Image size 1932x1910, color fundus image: 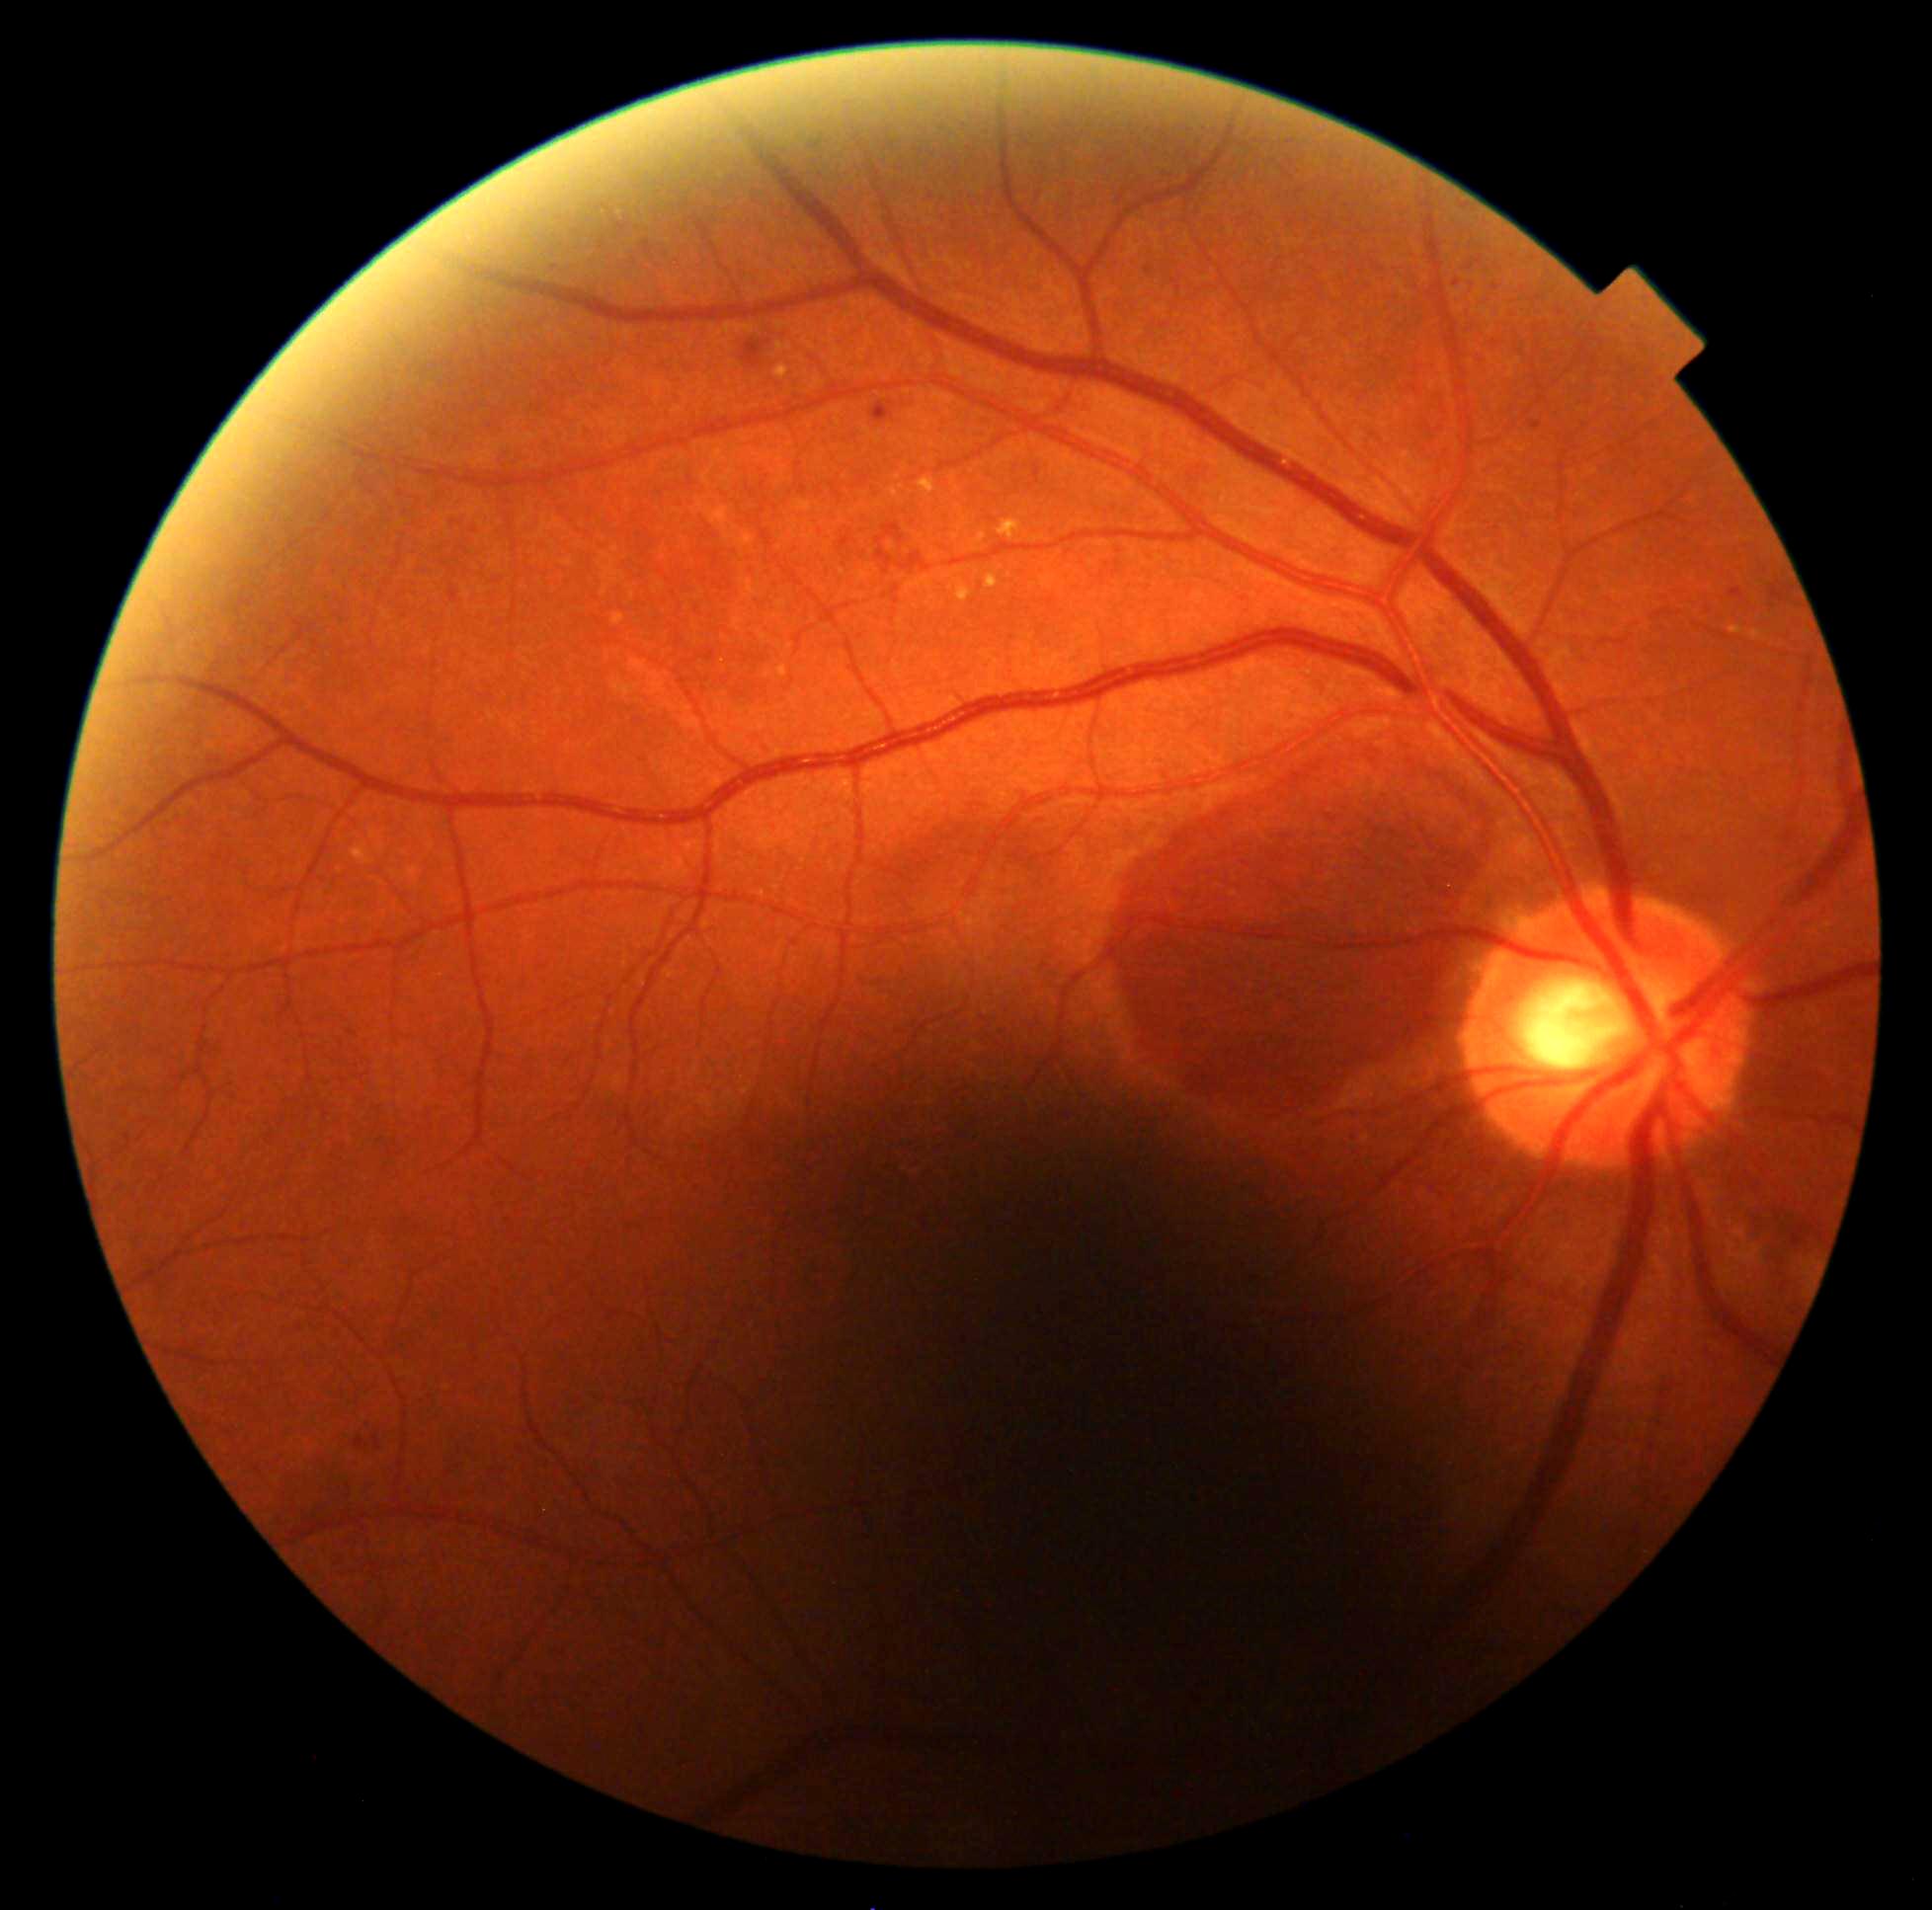 Diabetic retinopathy (DR): 2/4.